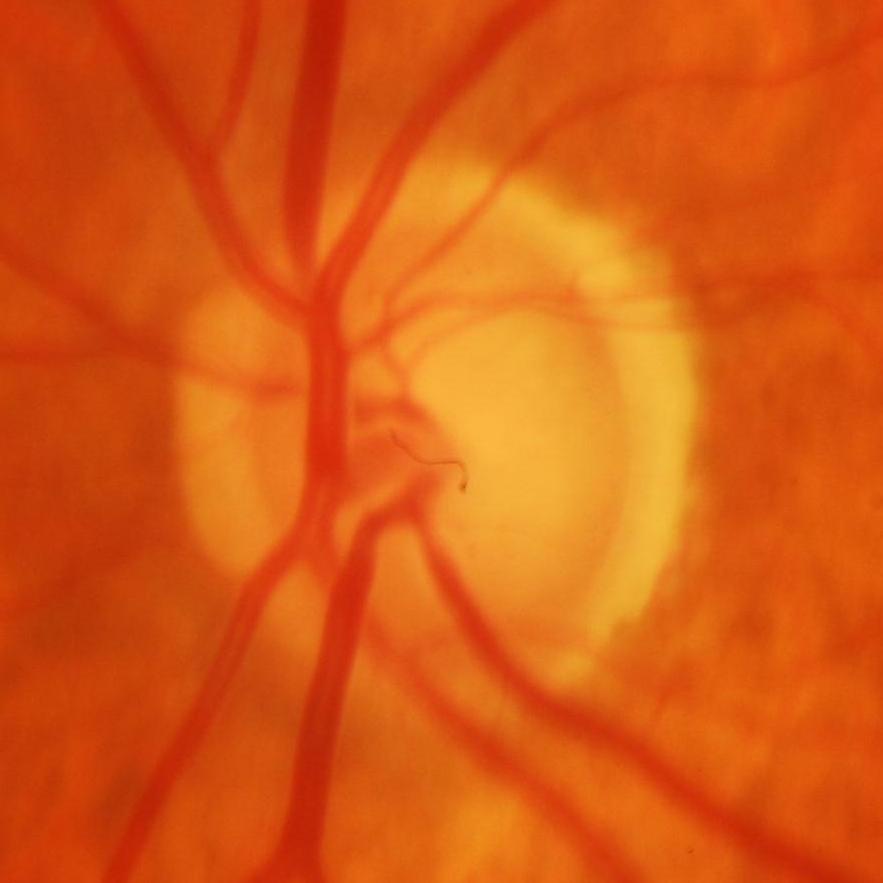
Assessment: glaucoma.